Dilated-pupil acquisition, color fundus photograph, image size 2228x1652, FOV: 50 degrees.
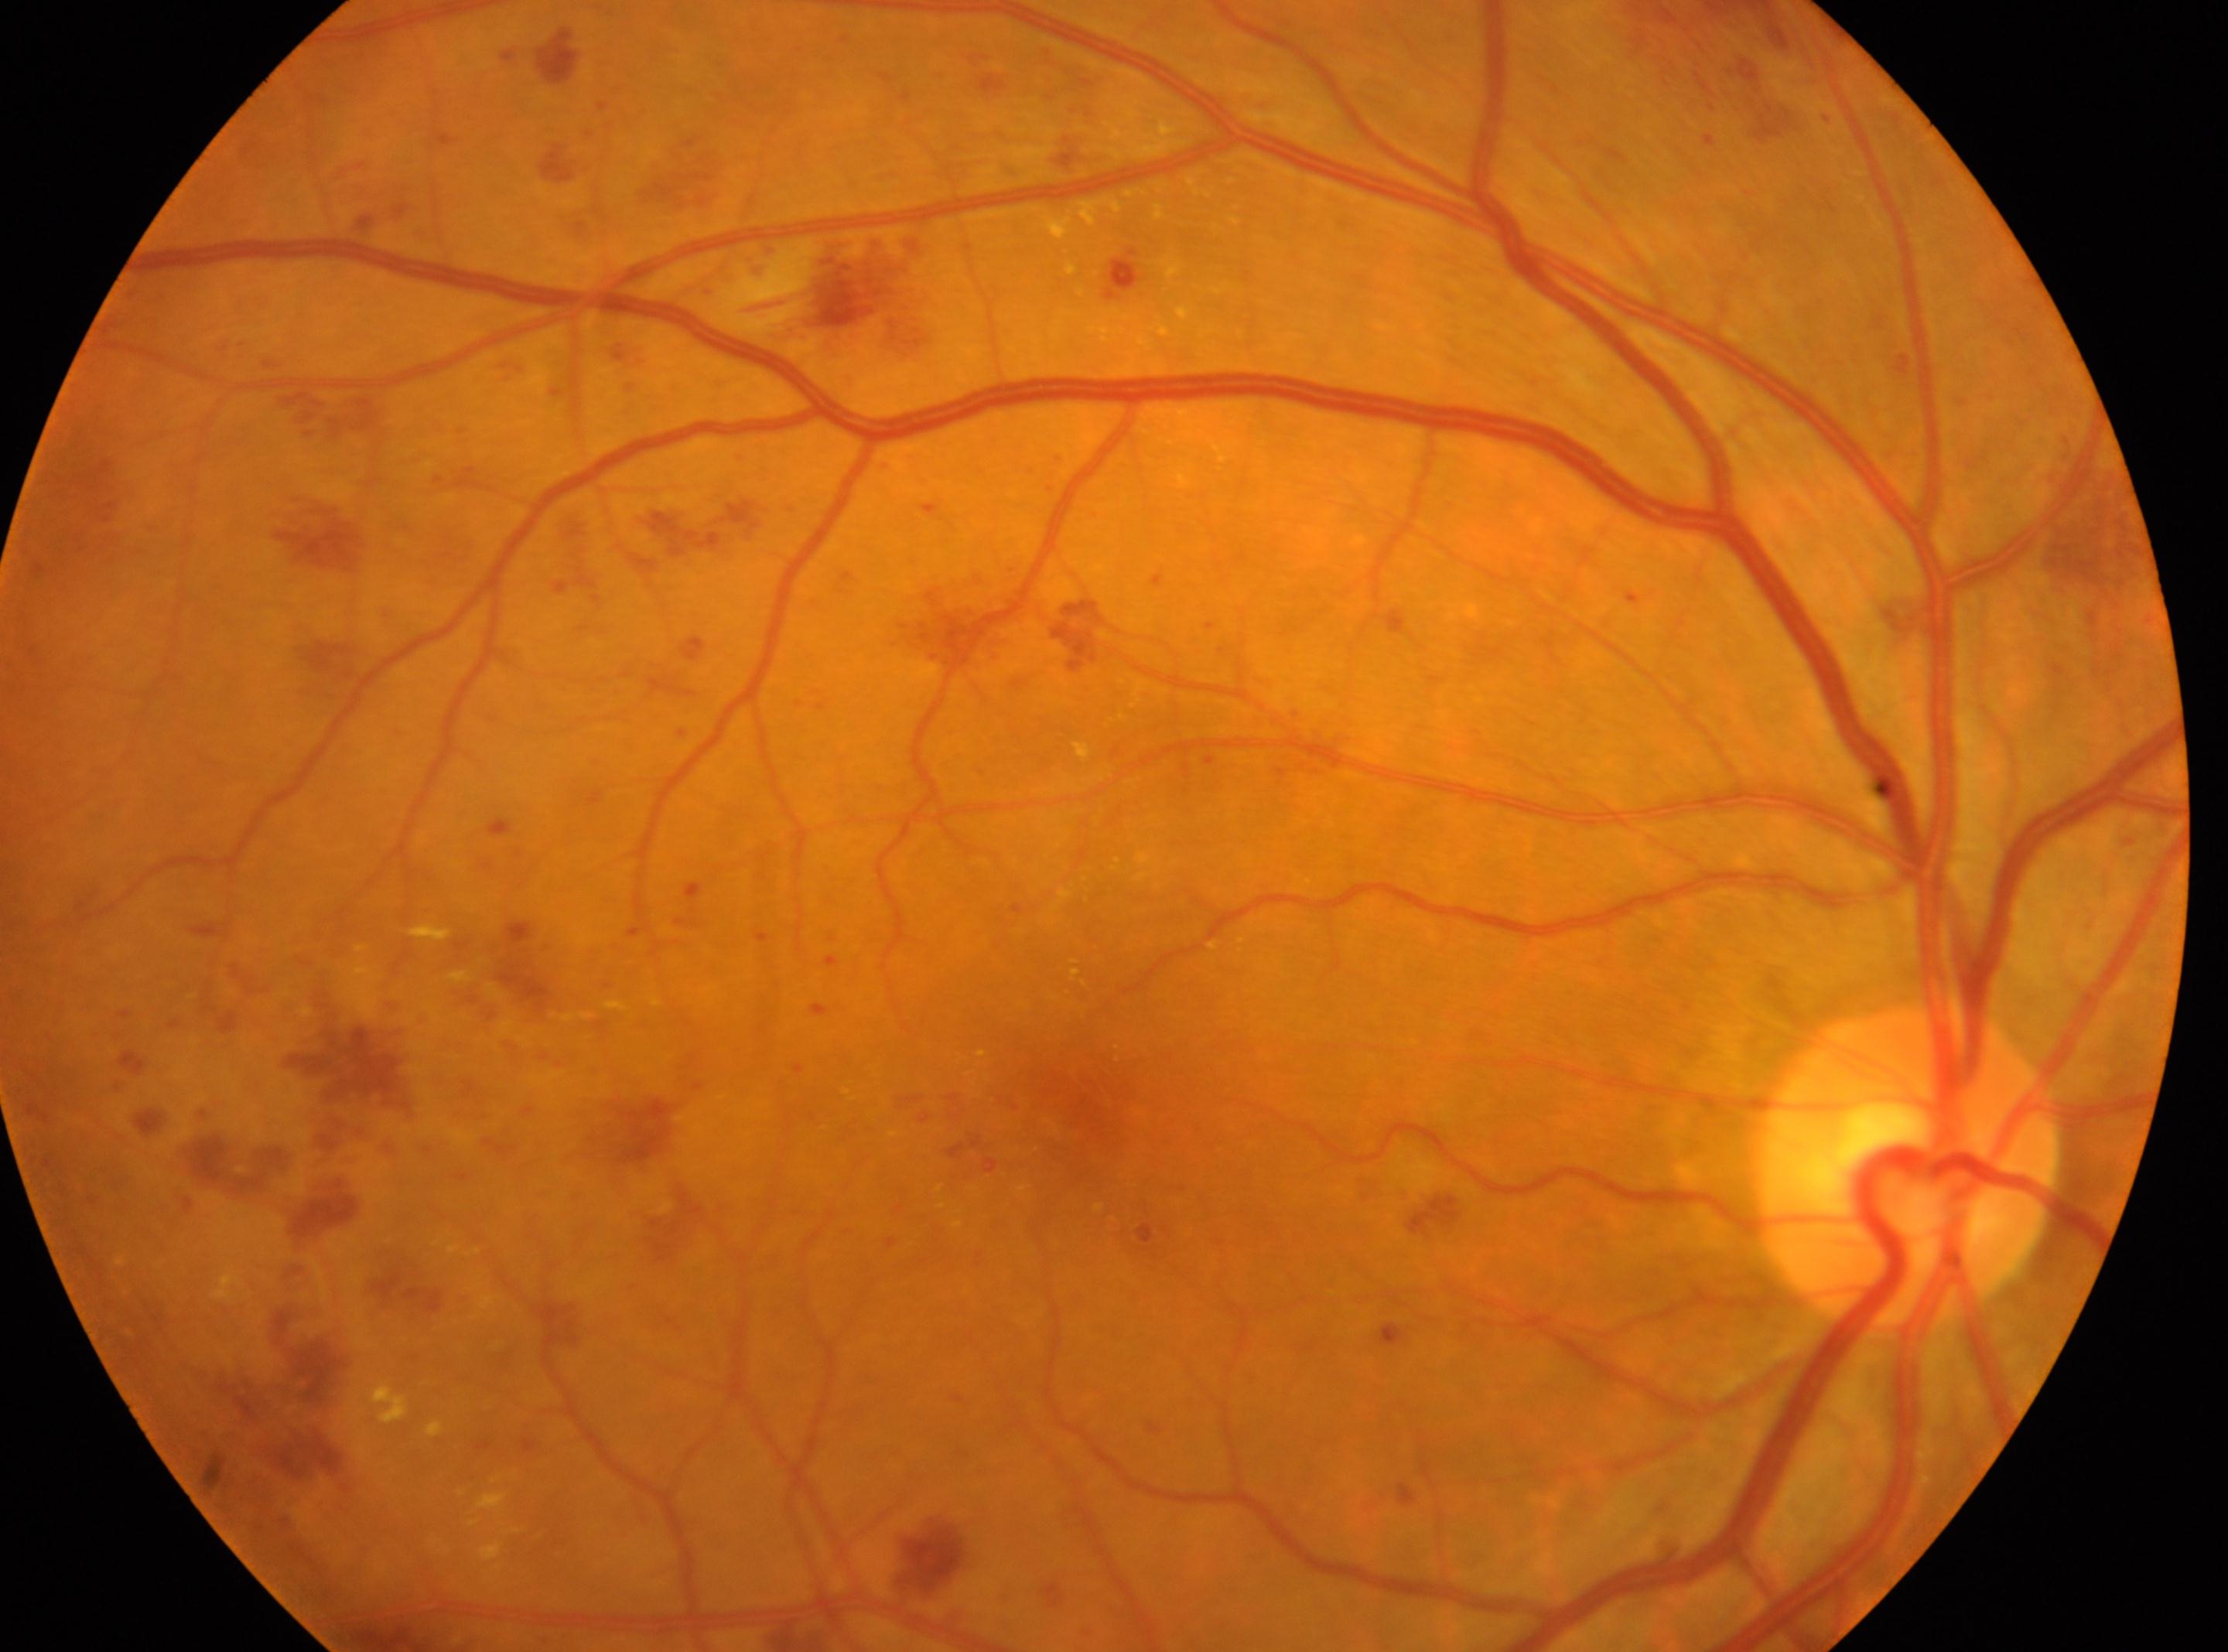

The fovea center is at (1064,1098).
Retinopathy grade: 3/4.
The optic disc center is at (1907,1163).
The image shows the oculus dexter.